45° FOV, CFP — 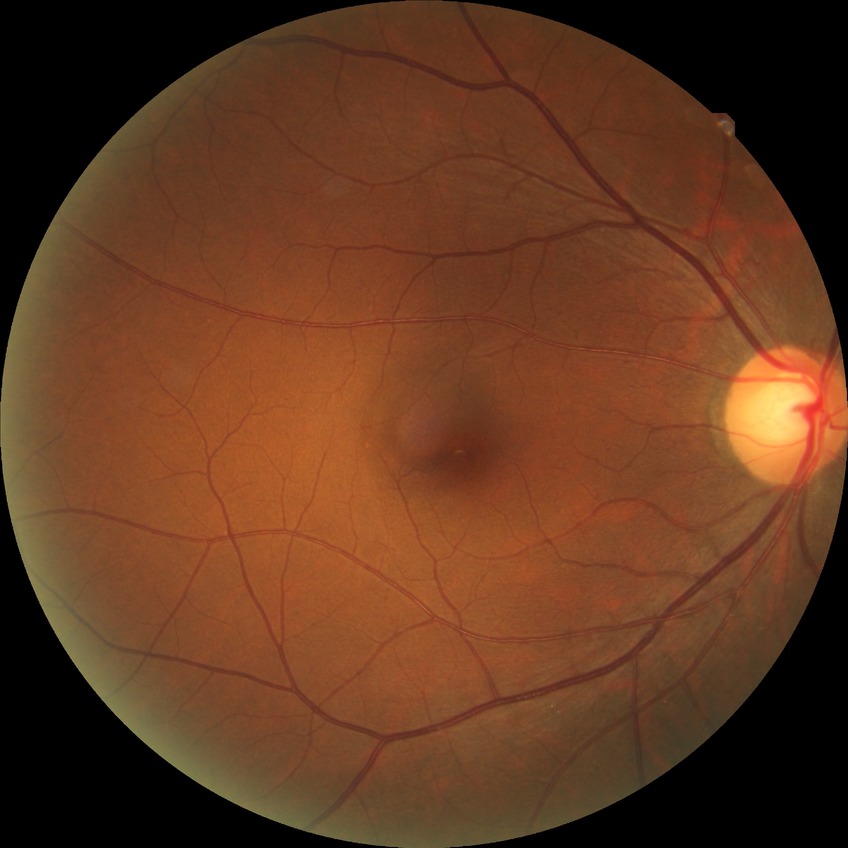
Davis grading: no diabetic retinopathy.